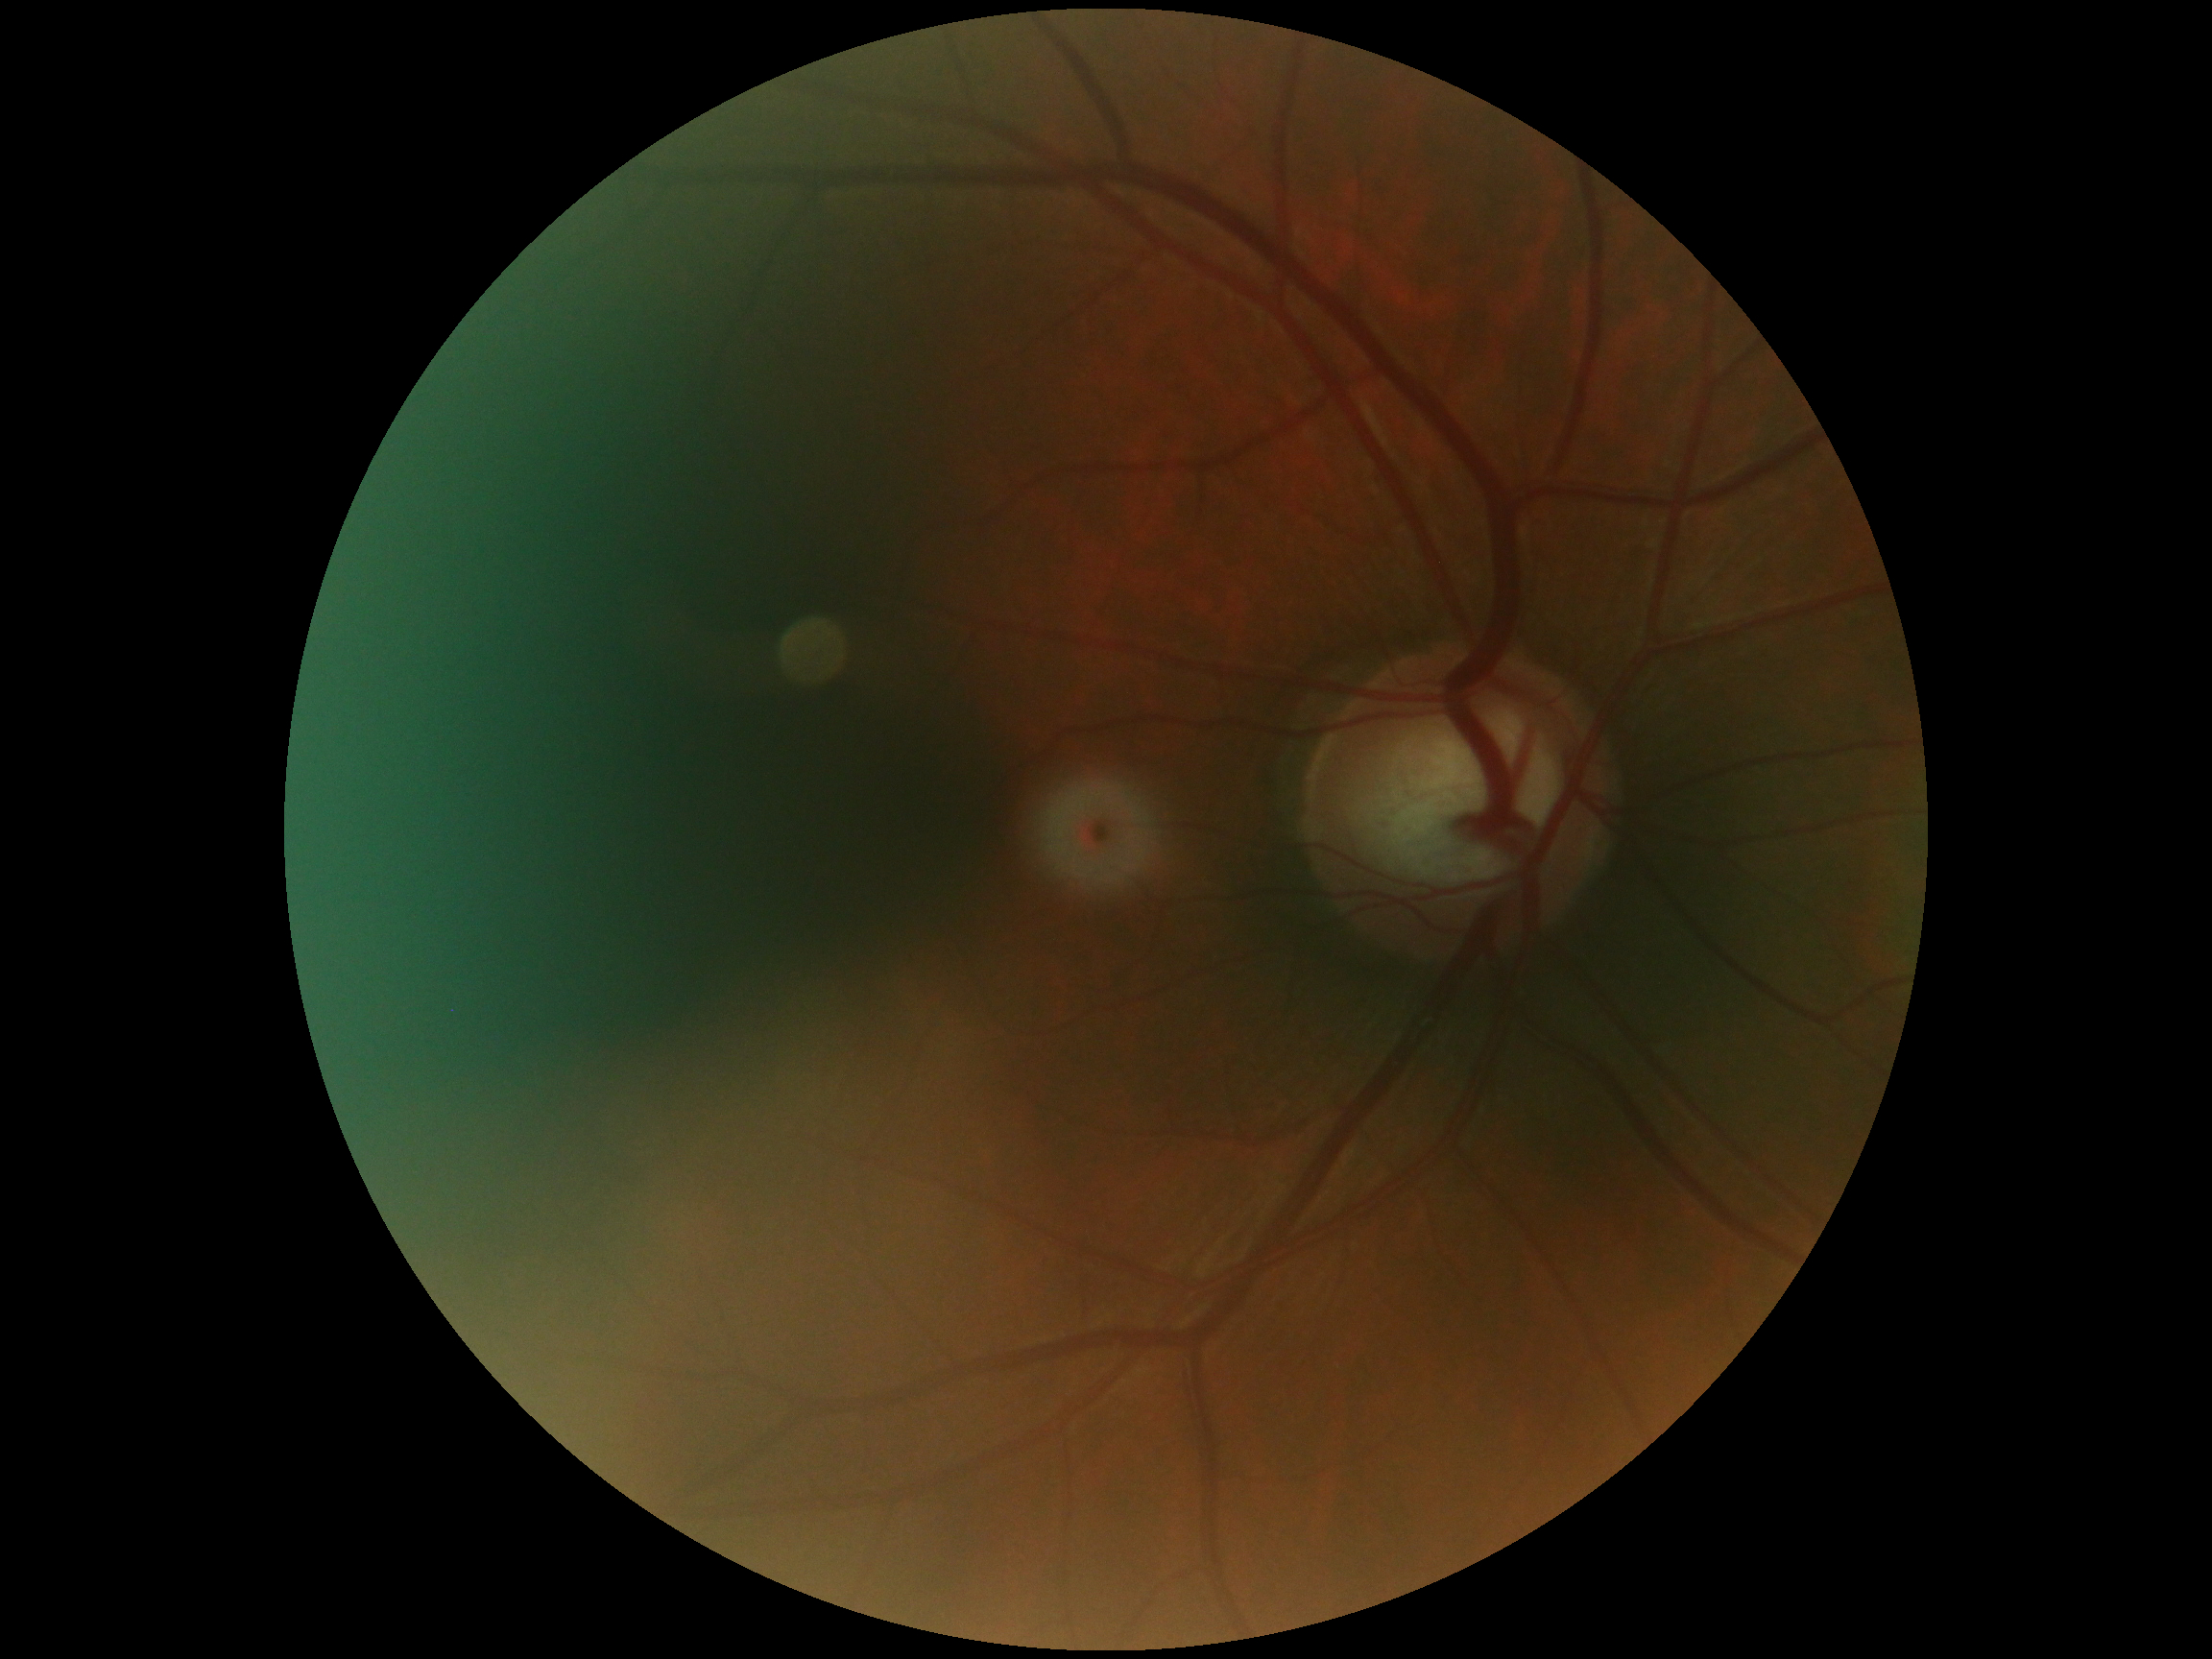

{
  "dr_grade": "0/4 — no visible signs of diabetic retinopathy"
}